Image size 240x240 — 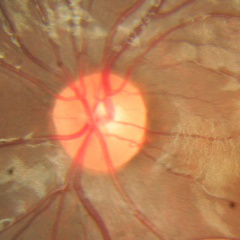

Color fundus photograph showing no glaucomatous findings.